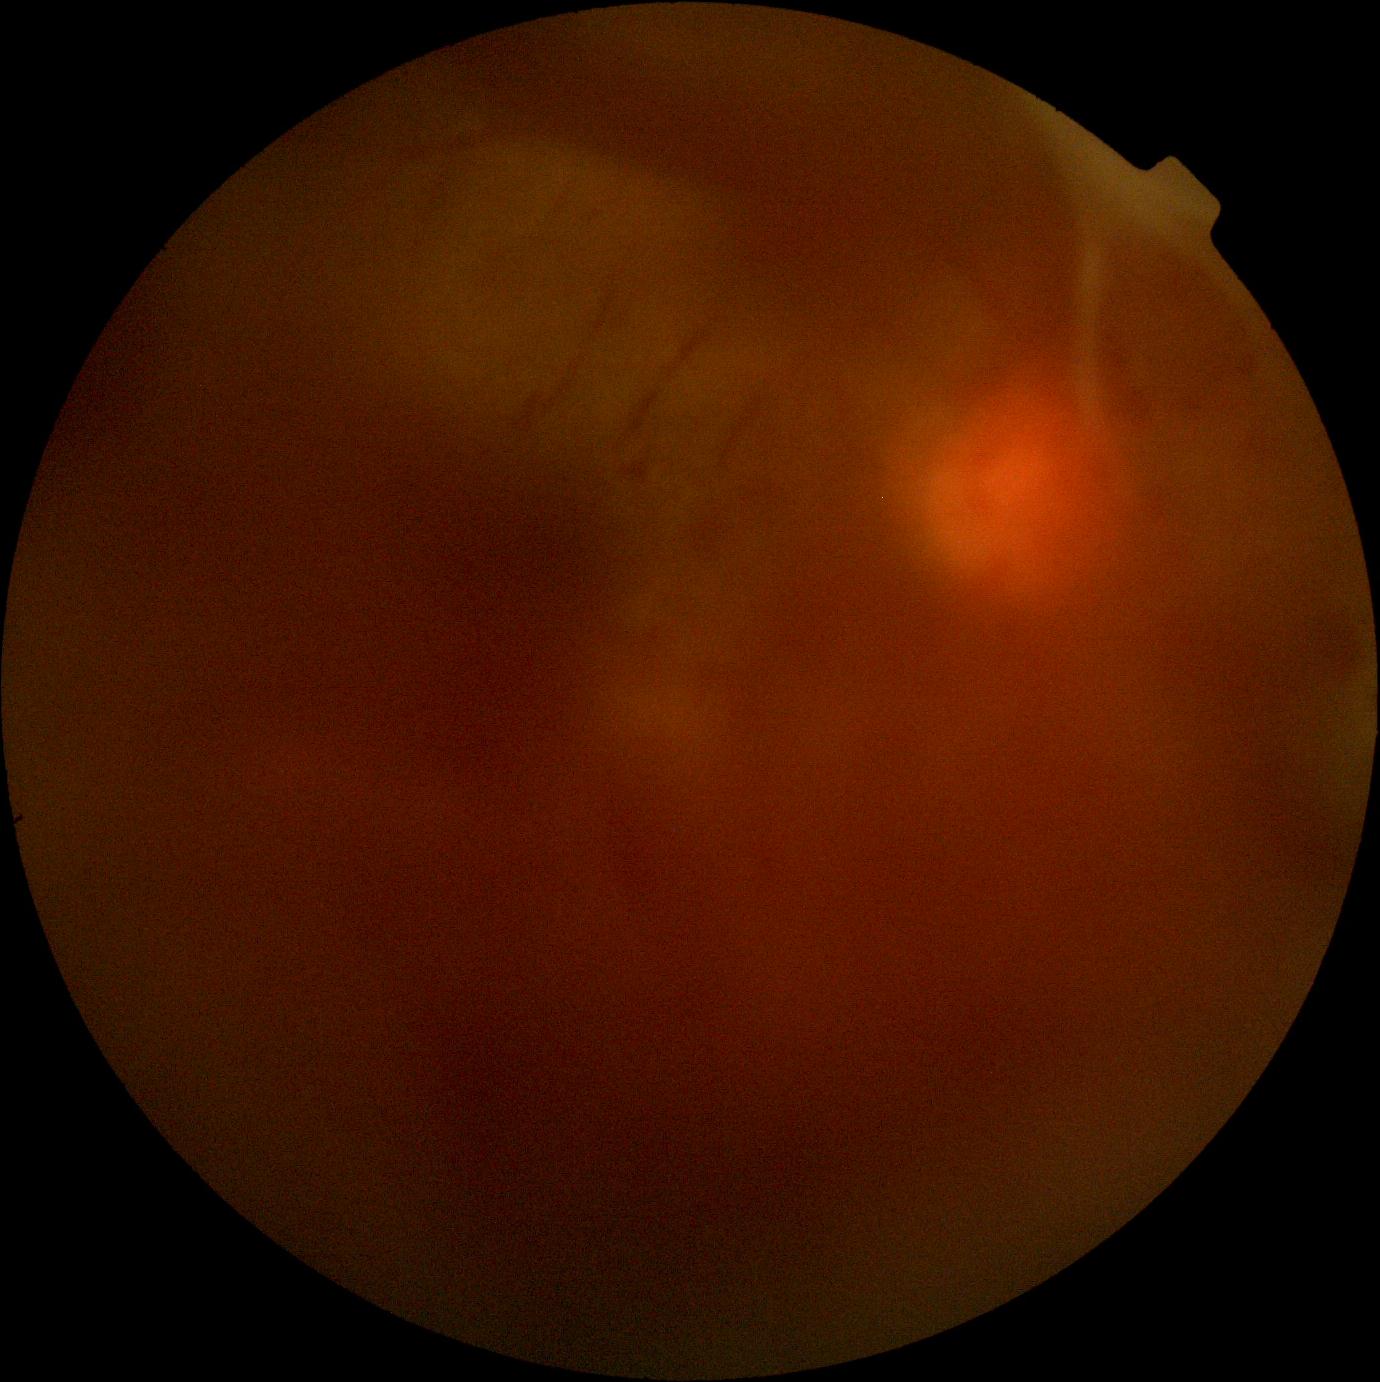 DR grade: PDR (4).